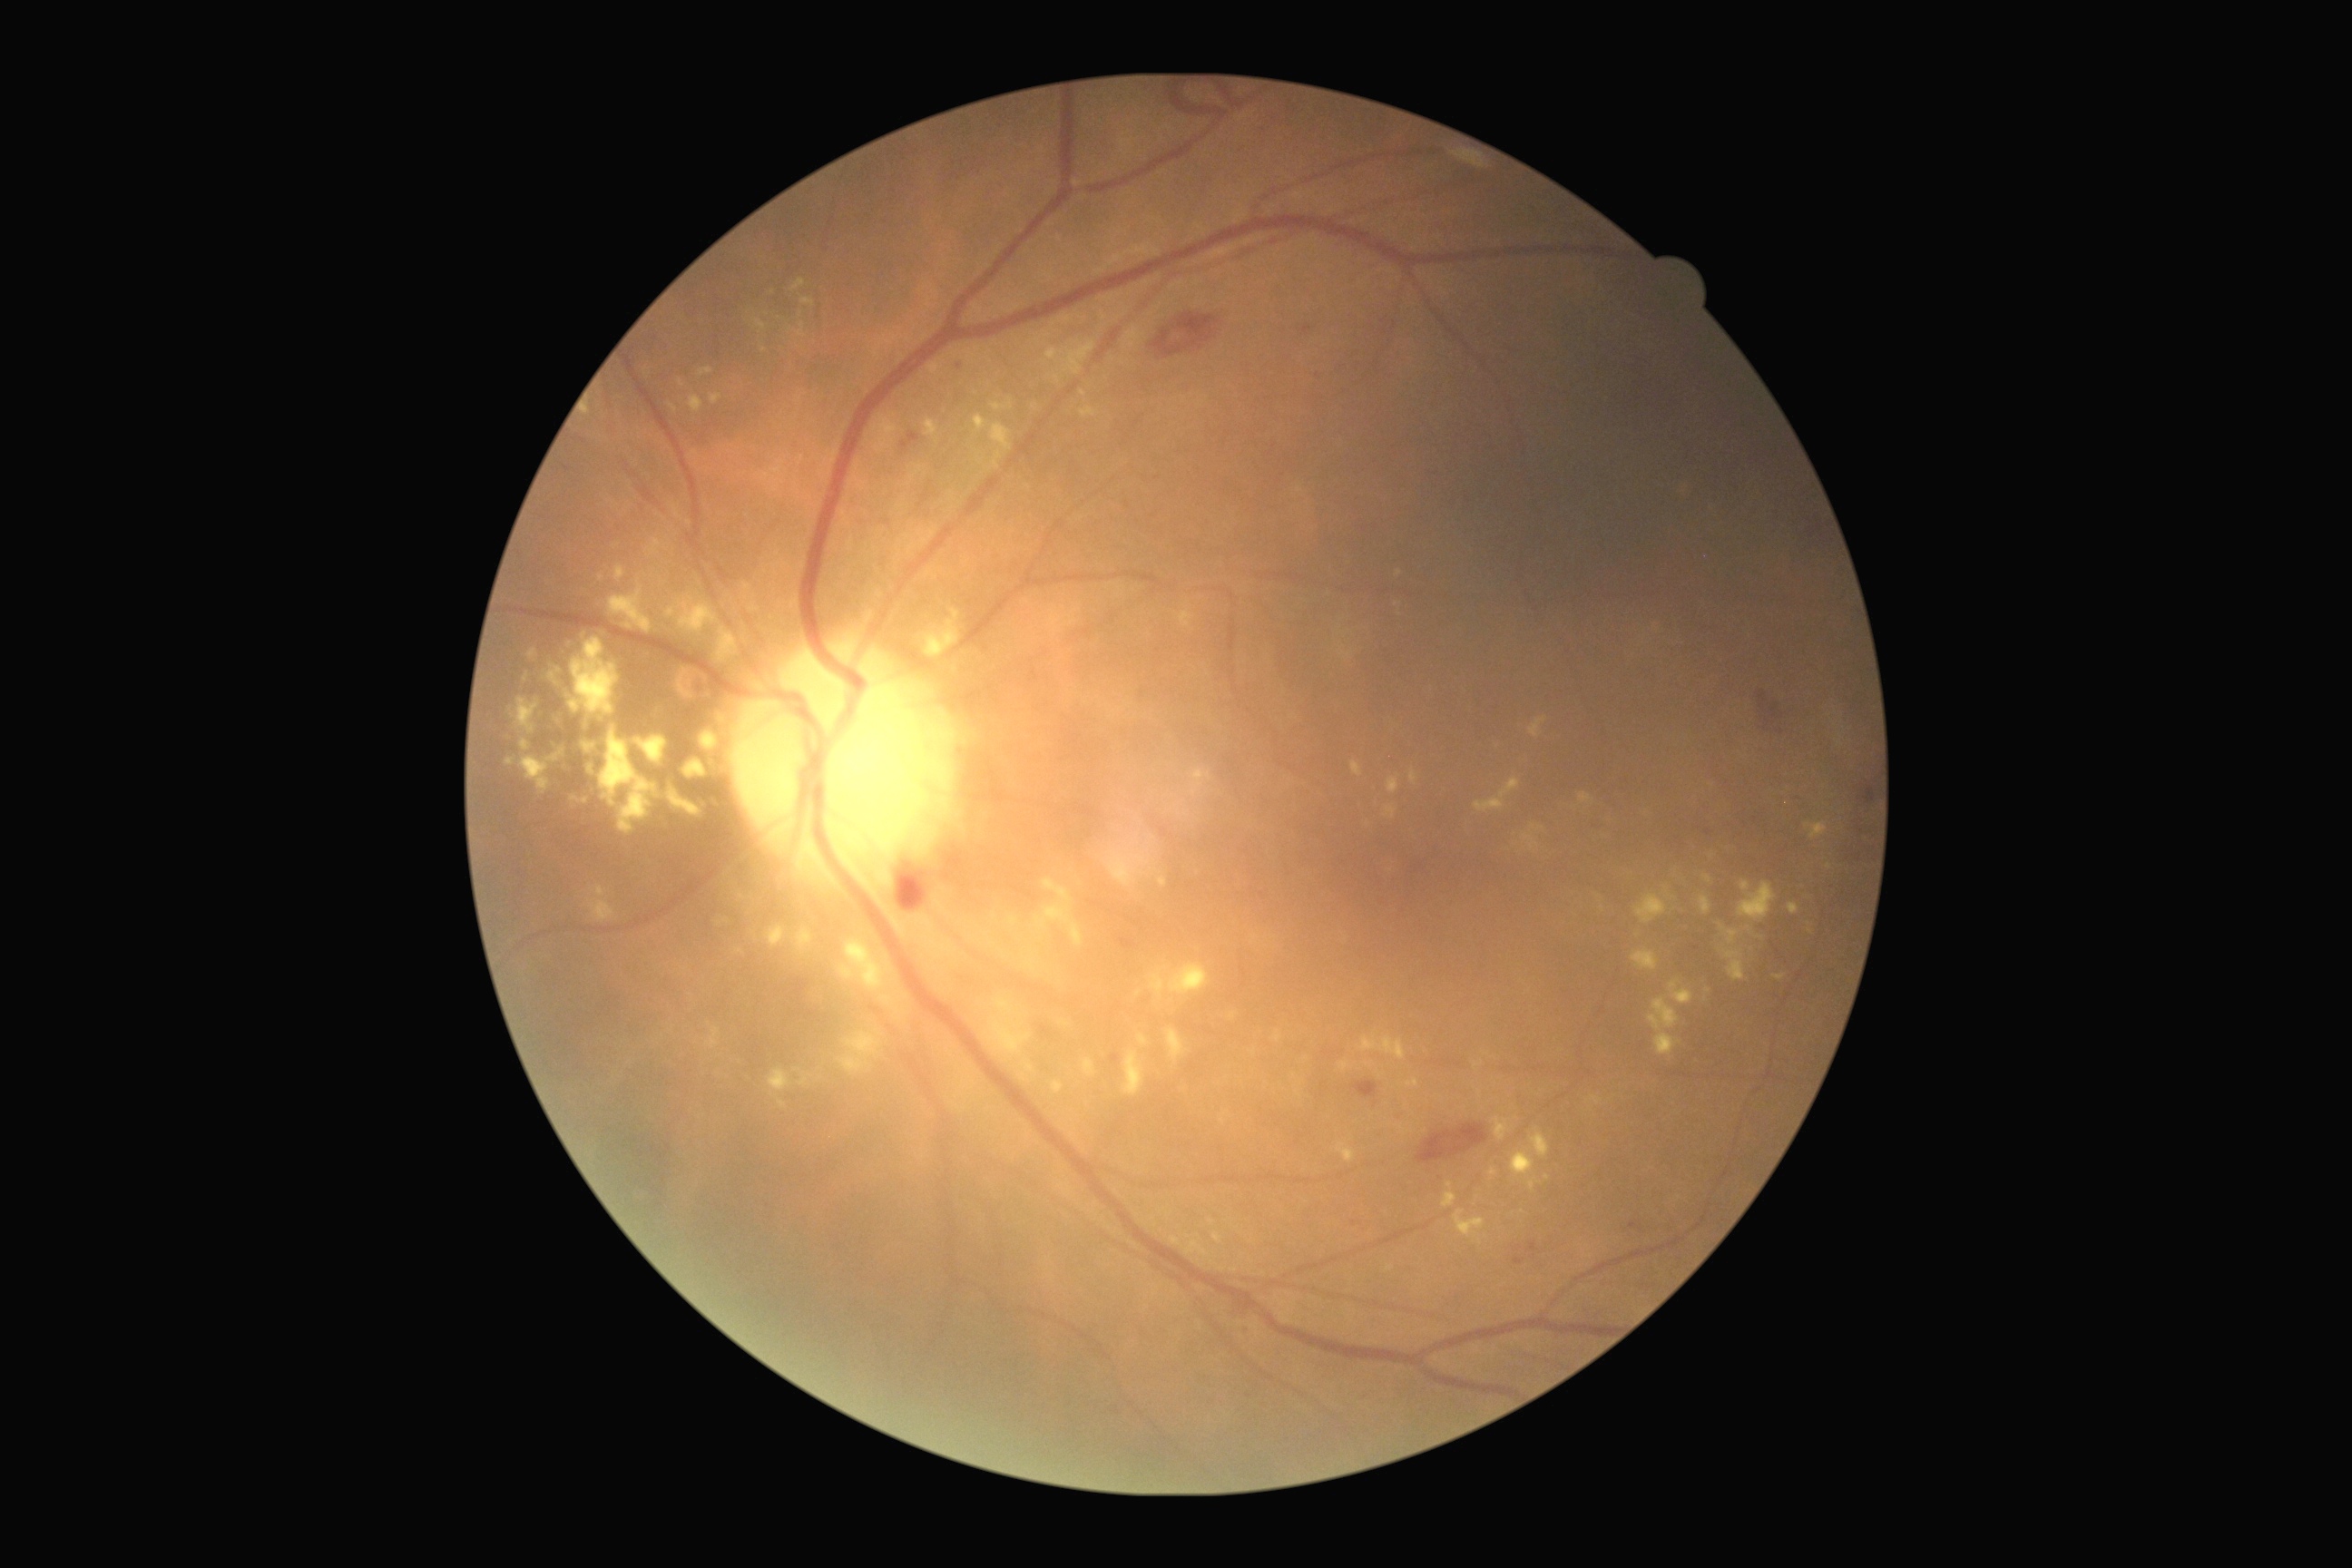

Diabetic retinopathy (DR) is 2.